Fundus photo:
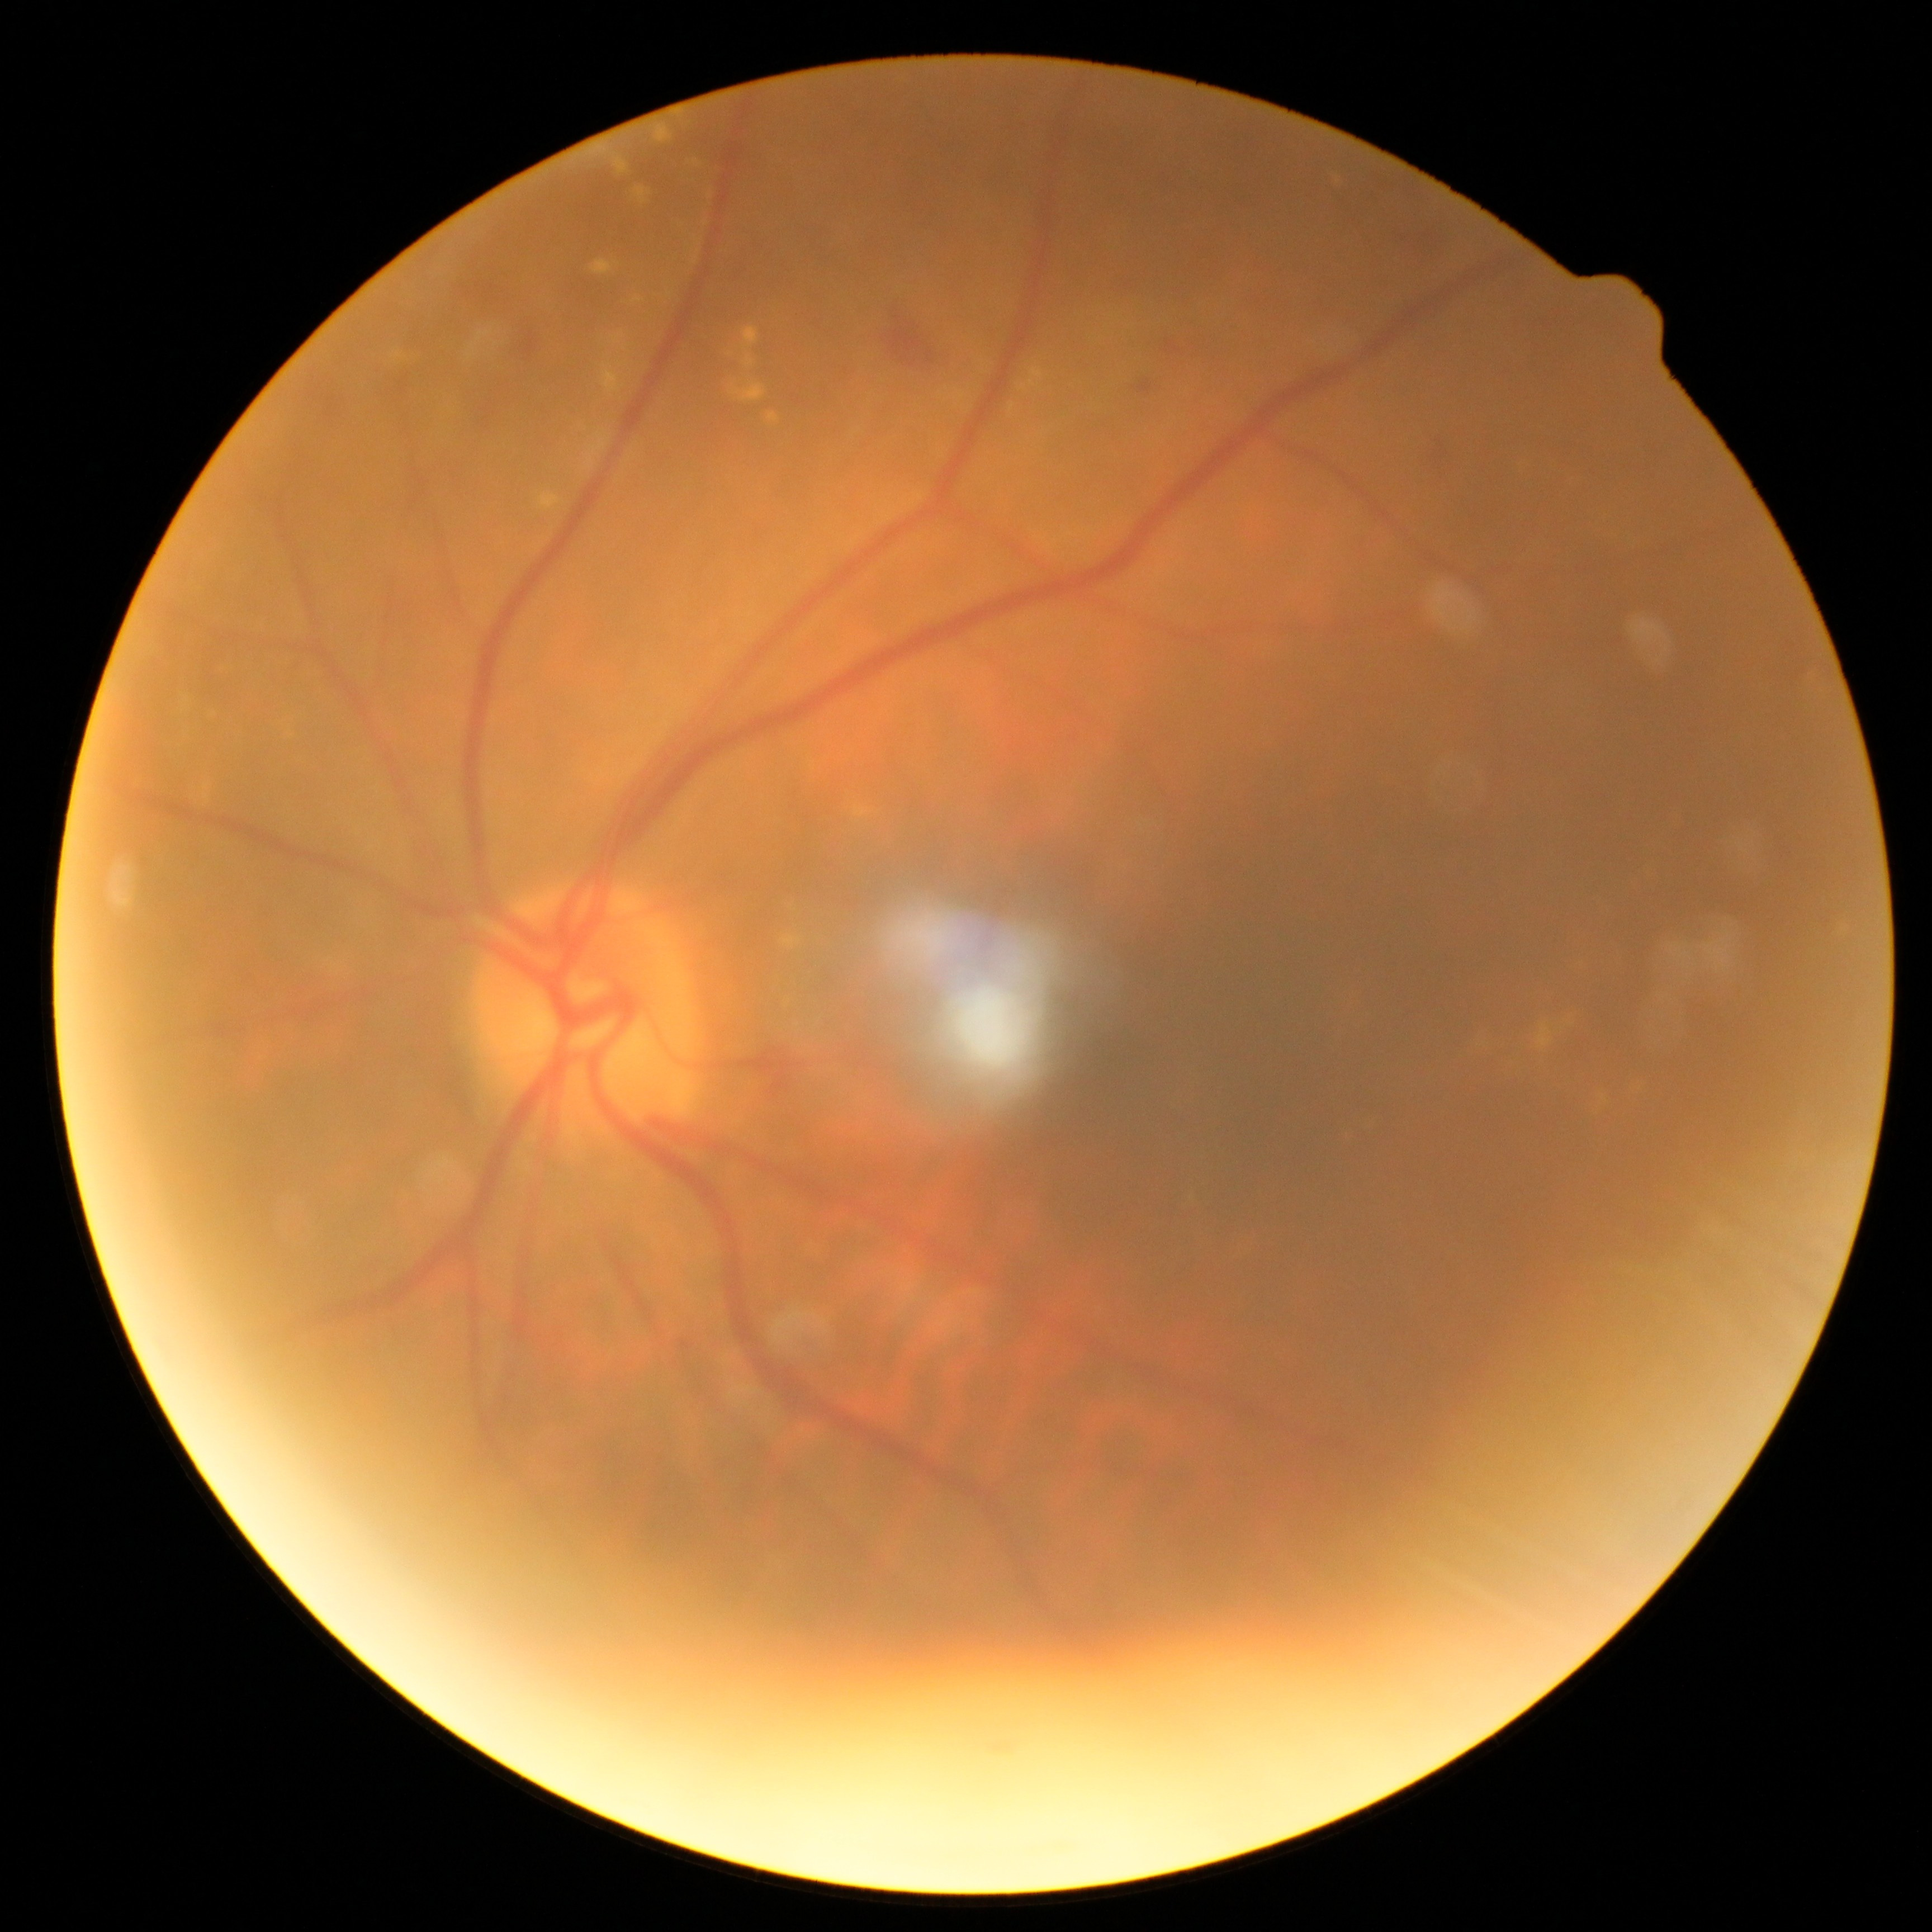 Findings:
– DR class — non-proliferative diabetic retinopathy
– diabetic retinopathy (DR) — grade 2 (moderate NPDR)